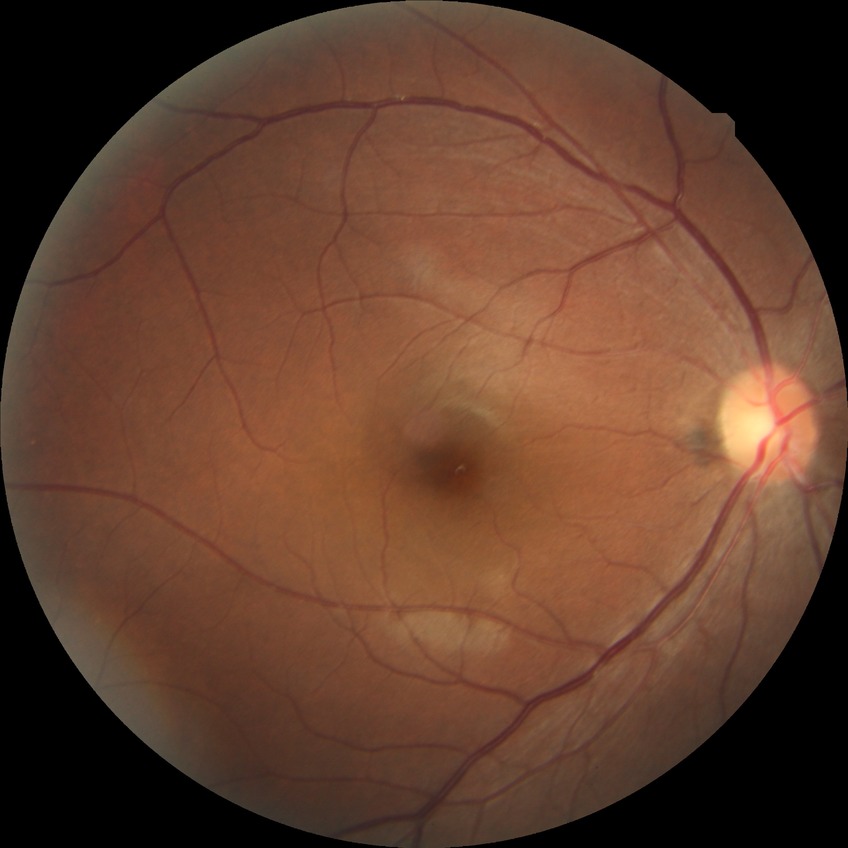
No apparent diabetic retinopathy. Modified Davis grade is NDR.